1240 by 1240 pixels. Pediatric wide-field fundus photograph:
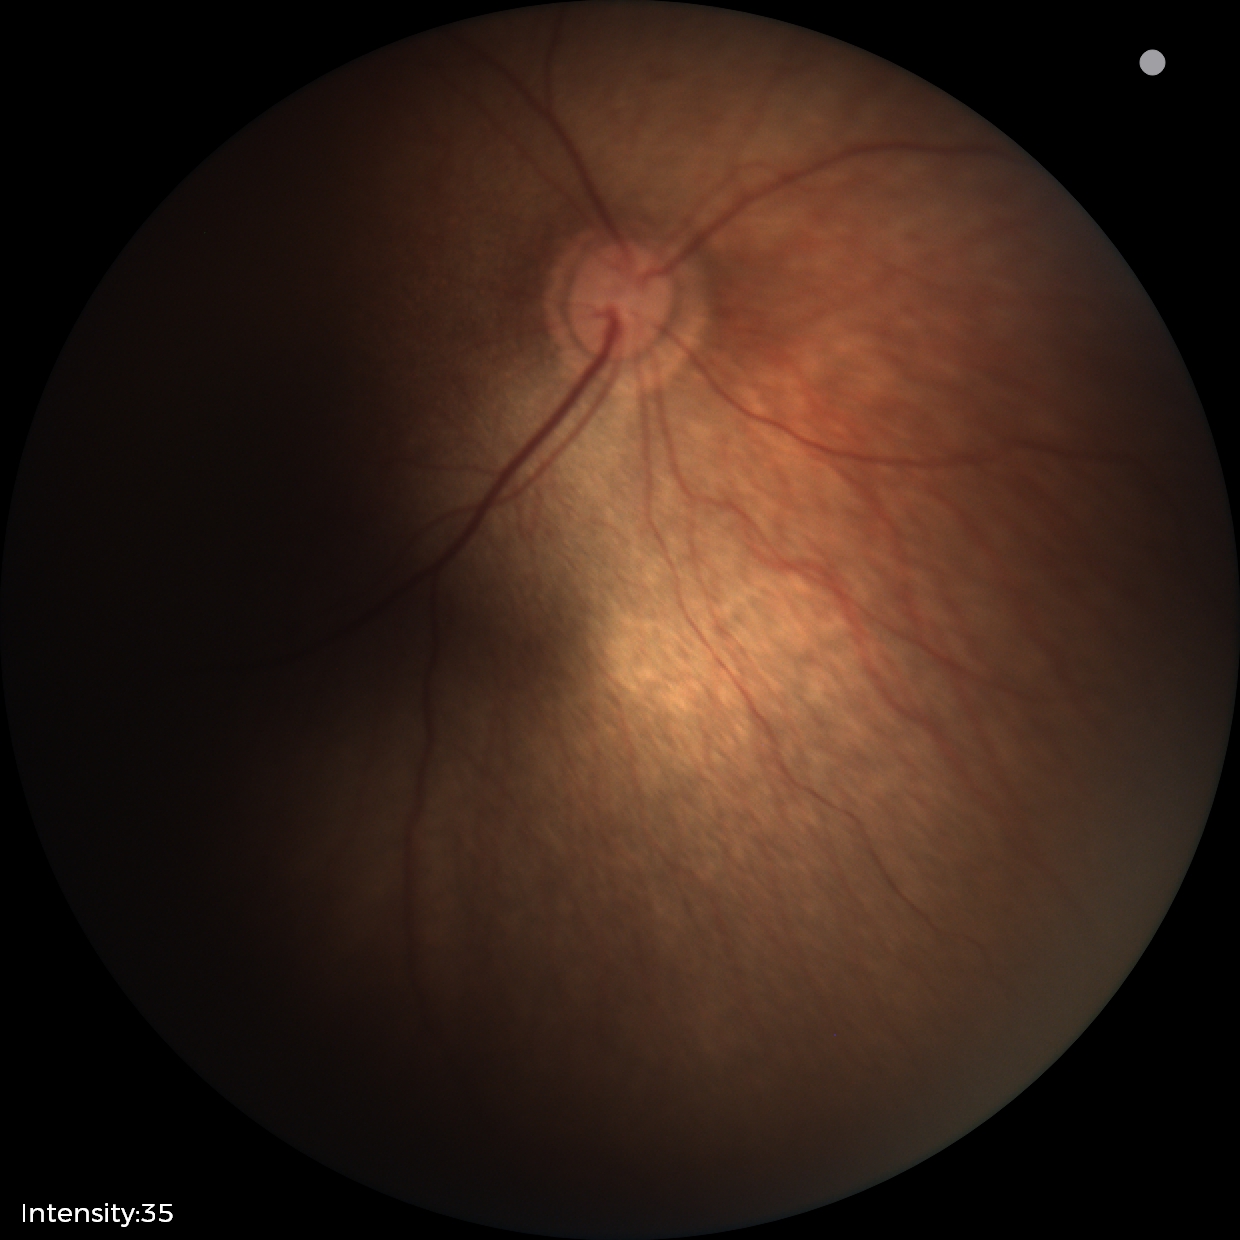
Impression = no abnormalities